Phoenix ICON wide-field infant fundus image: 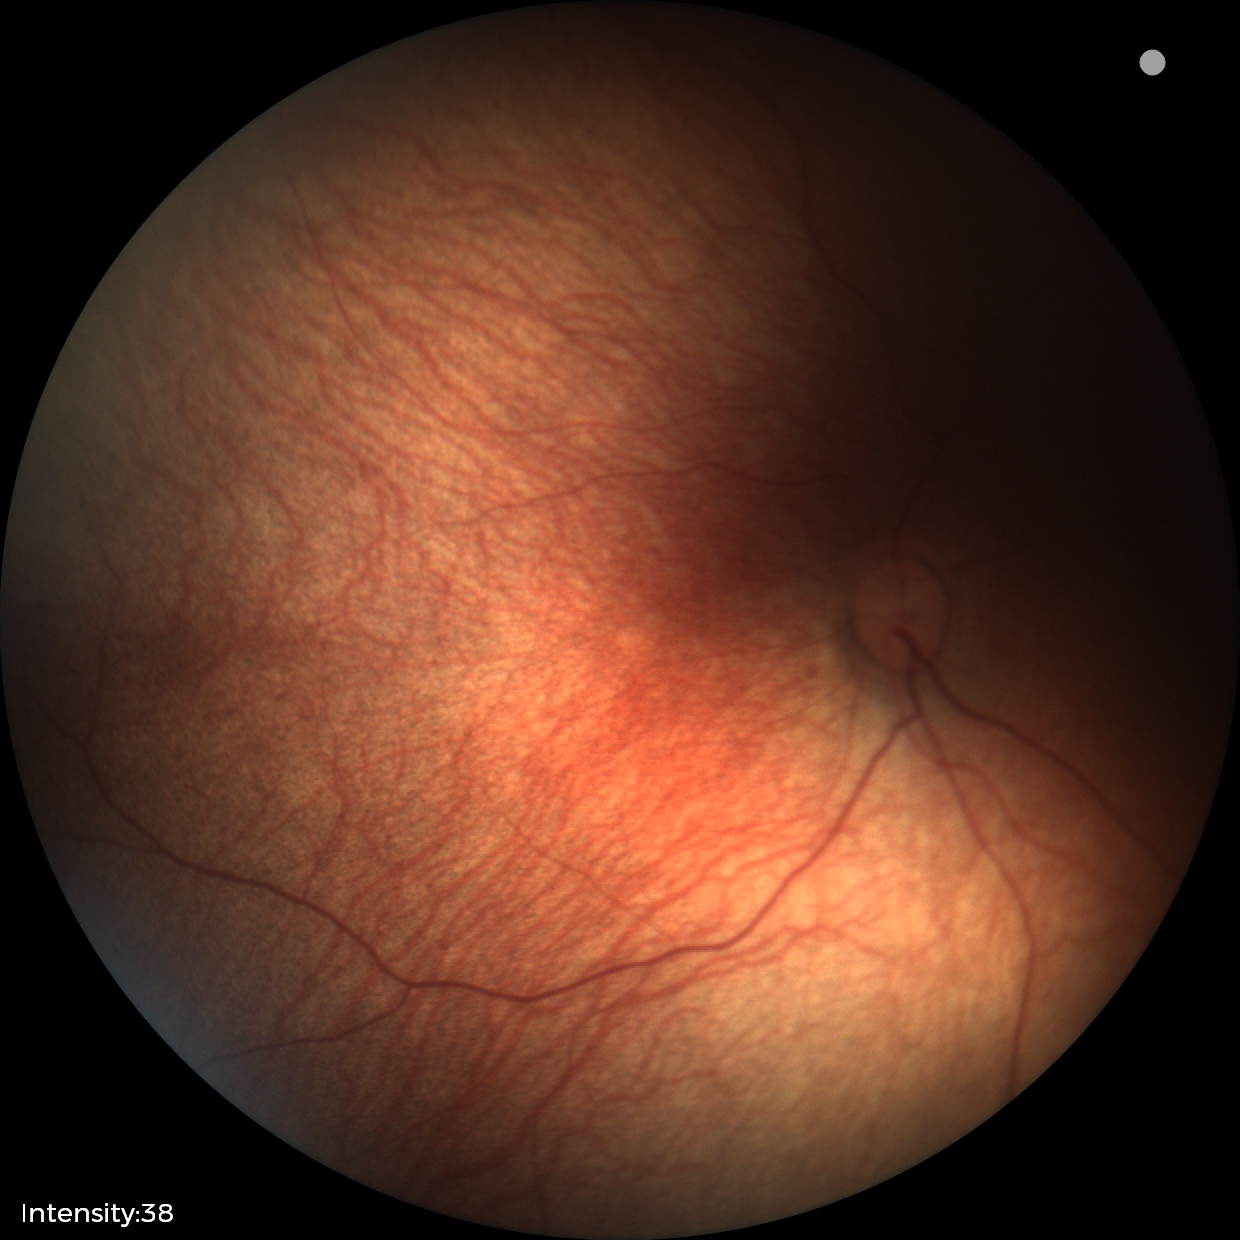

Screening: normal fundus examination.